Wide-field fundus photograph from neonatal ROP screening · image size 640x480: 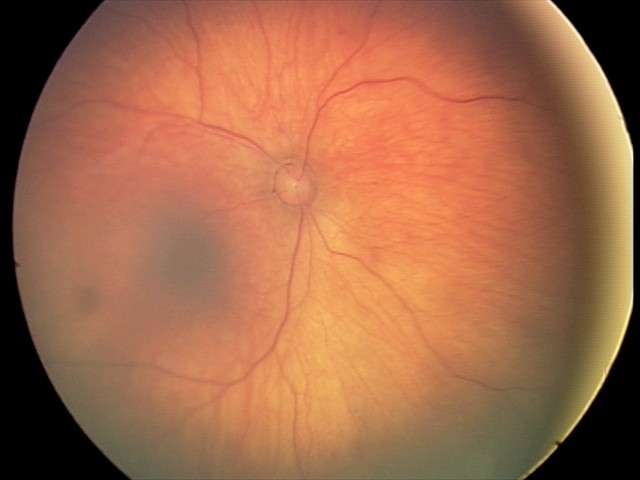
Screening series with retinal hemorrhages.